640 by 480 pixels · RetCam wide-field infant fundus image: 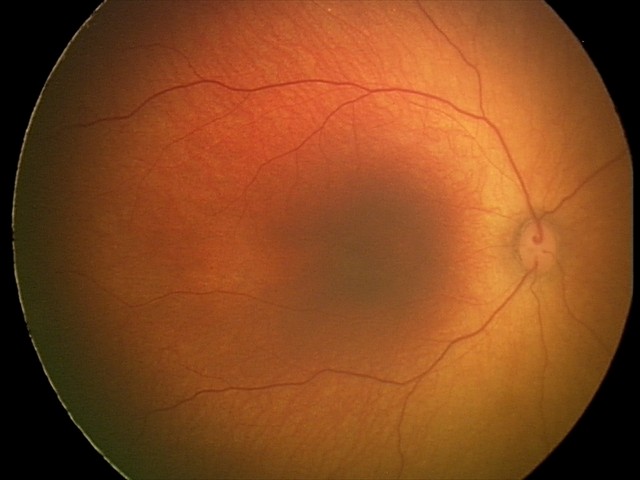

Q: What is the screening diagnosis?
A: physiological appearance with no retinal pathology